Davis DR grading · acquired with a NIDEK AFC-230 · CFP:
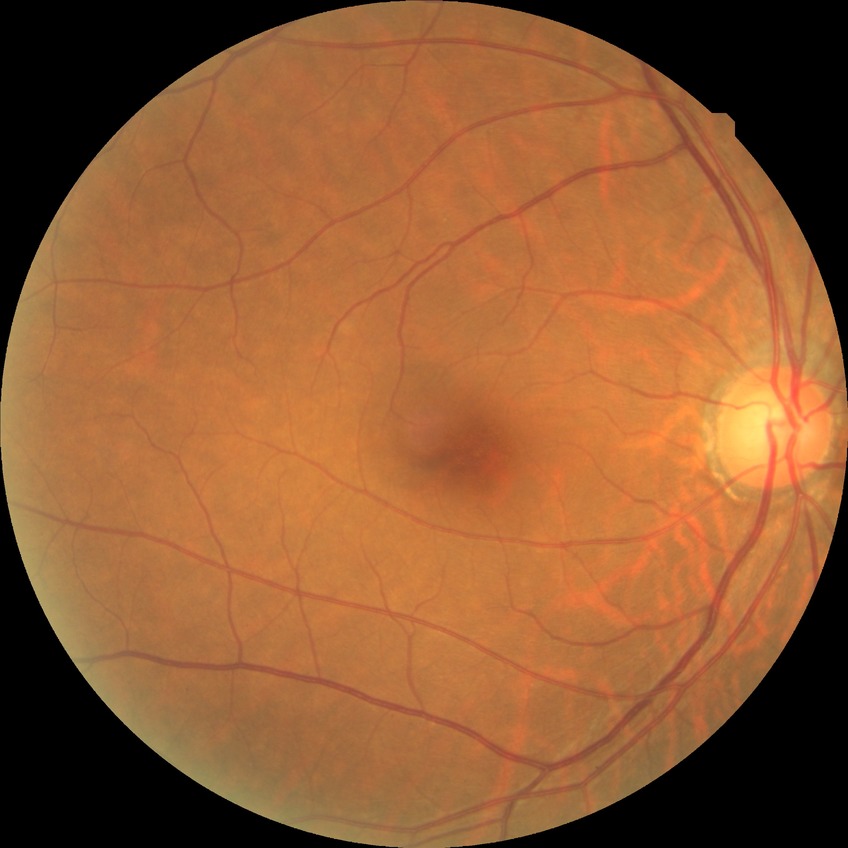
{
  "dr_impression": "no signs of DR",
  "davis_grade": "NDR"
}